Wide-field retinal mosaic image. 1924x1556
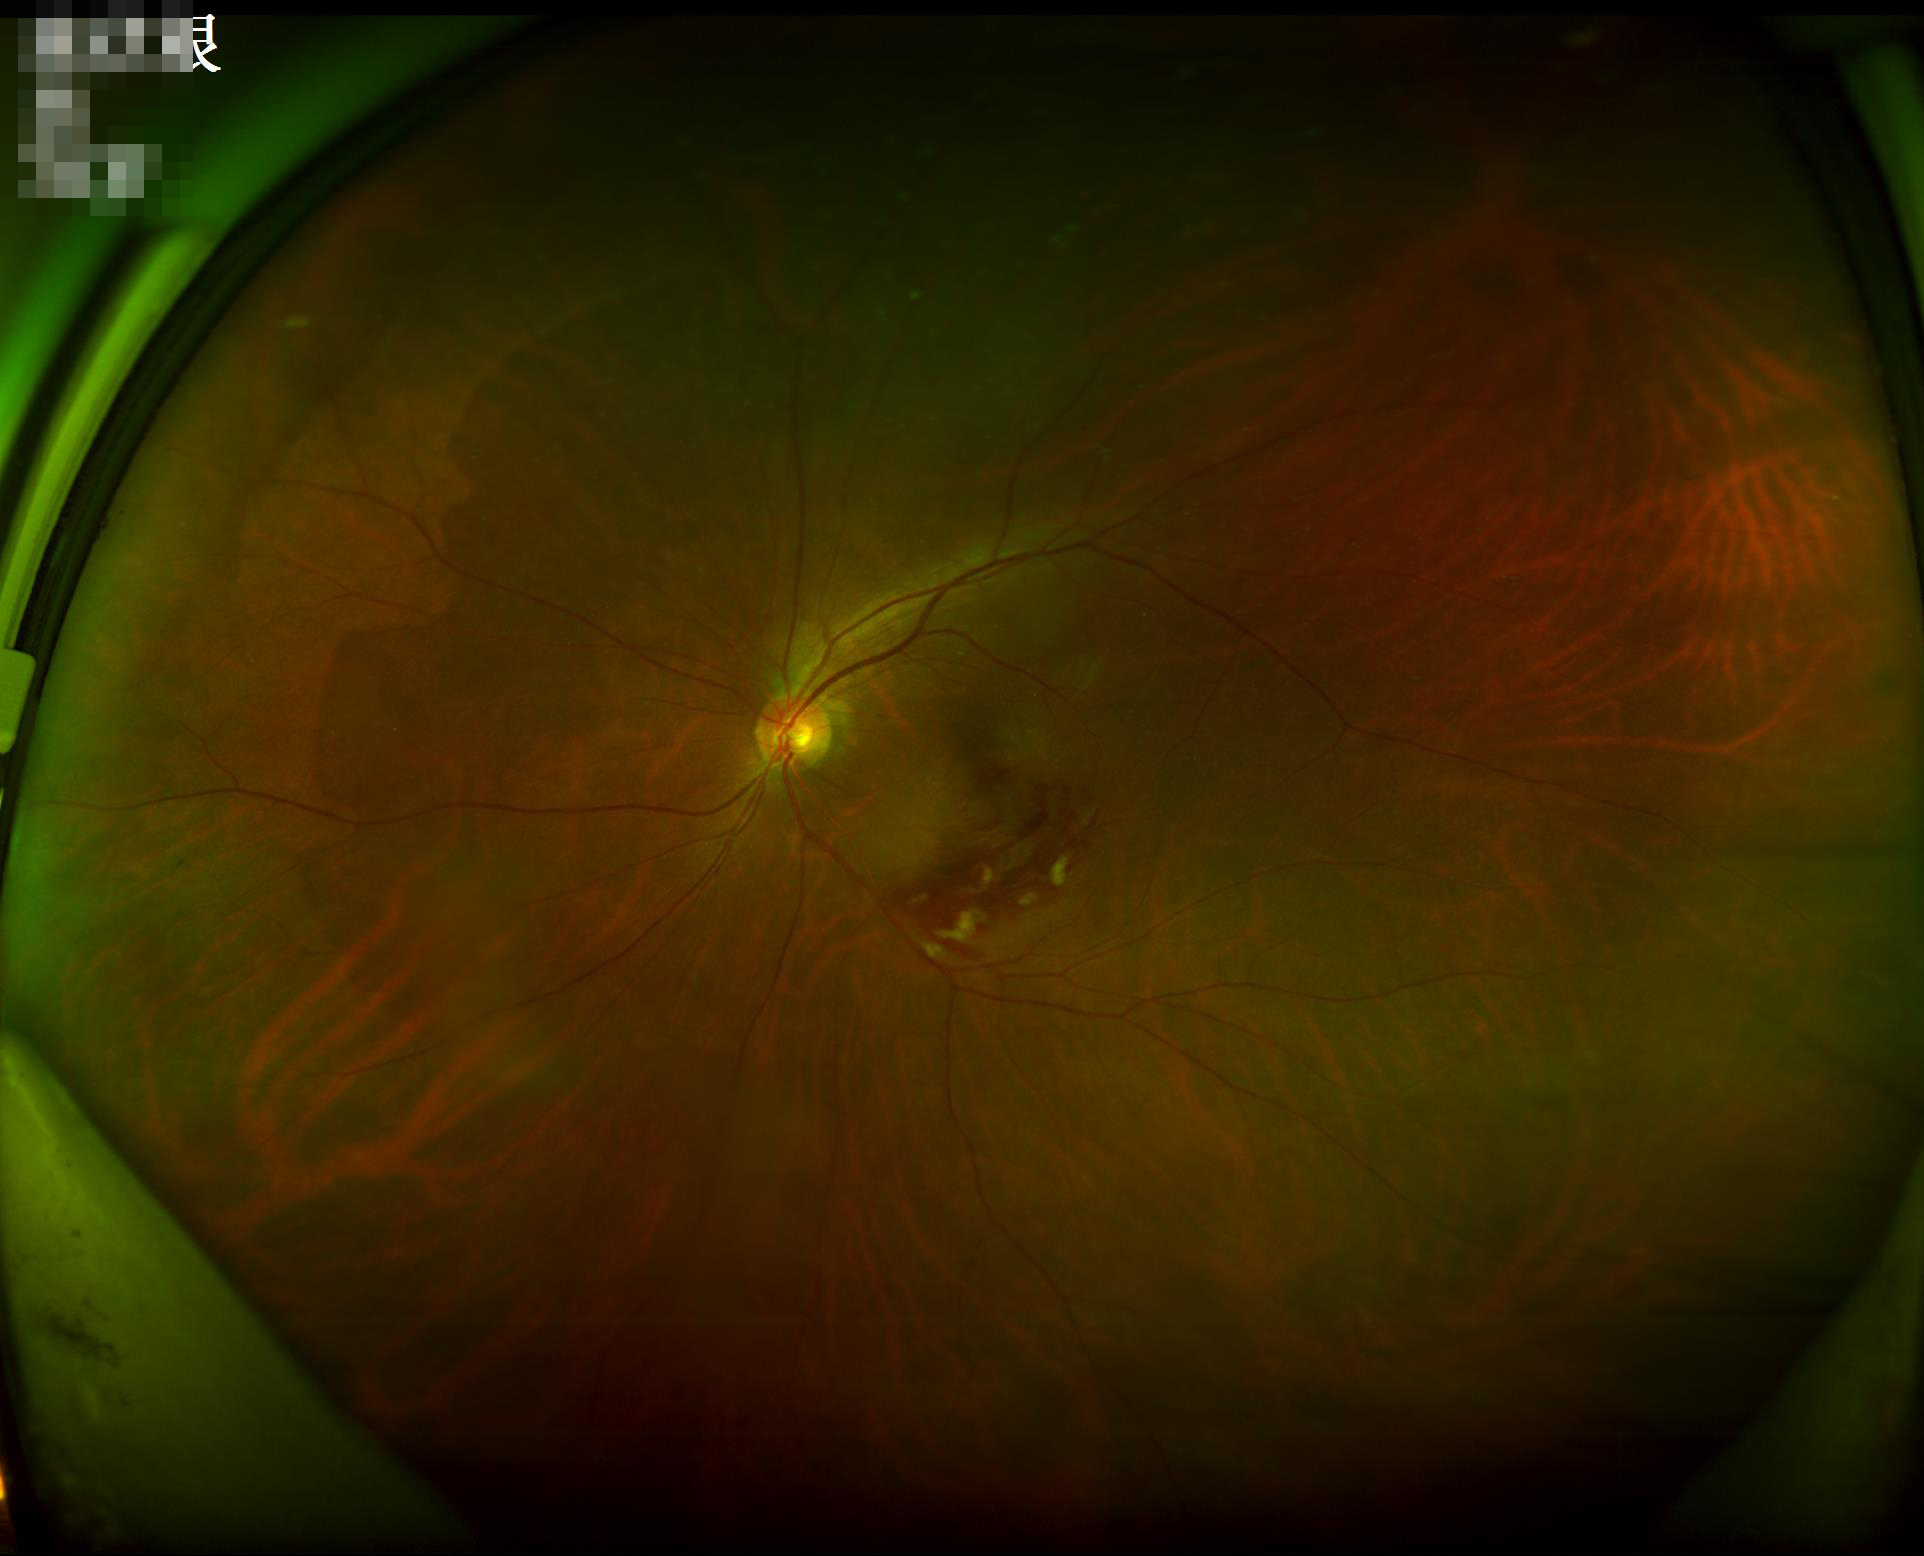
Illumination is even.
Contrast is good.
Overall quality is good and the image is gradable.
Optic disc, vessels, and background are in focus.